848 by 848 pixels · nonmydriatic · camera: NIDEK AFC-230 · 45-degree field of view — 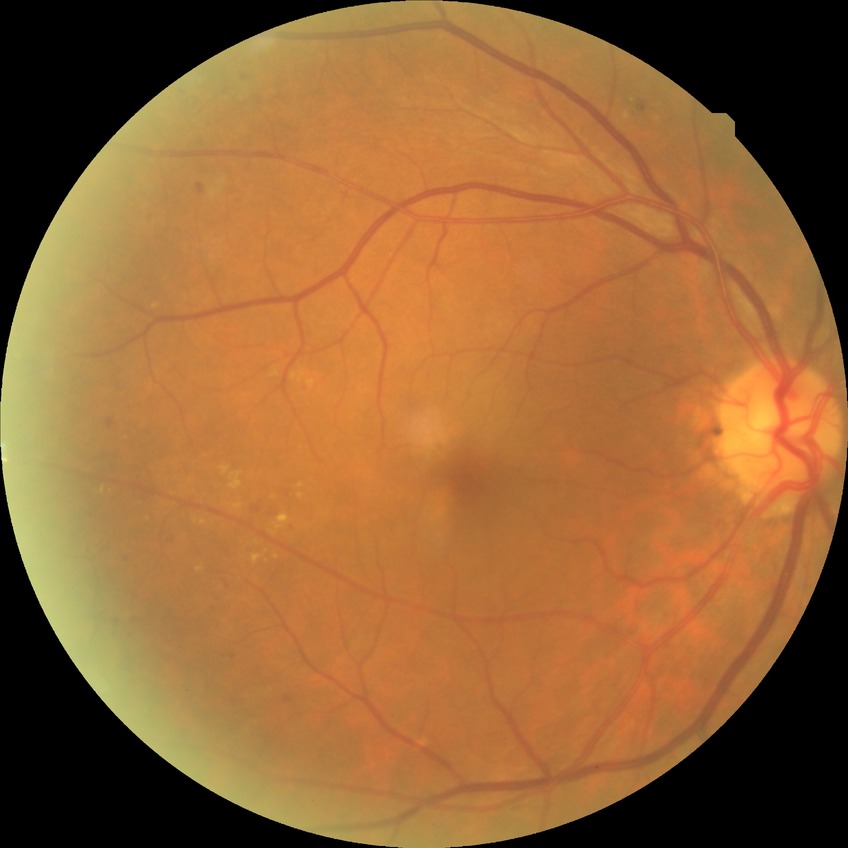
diabetic retinopathy (DR): SDR (simple diabetic retinopathy).